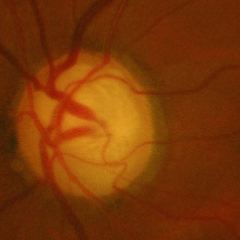
Glaucomatous optic neuropathy is present. Fundus appearance consistent with advanced glaucomatous optic neuropathy. (Criteria: near-total cupping of the optic nerve head, with or without severe visual field loss within the central 10 degrees of fixation.)